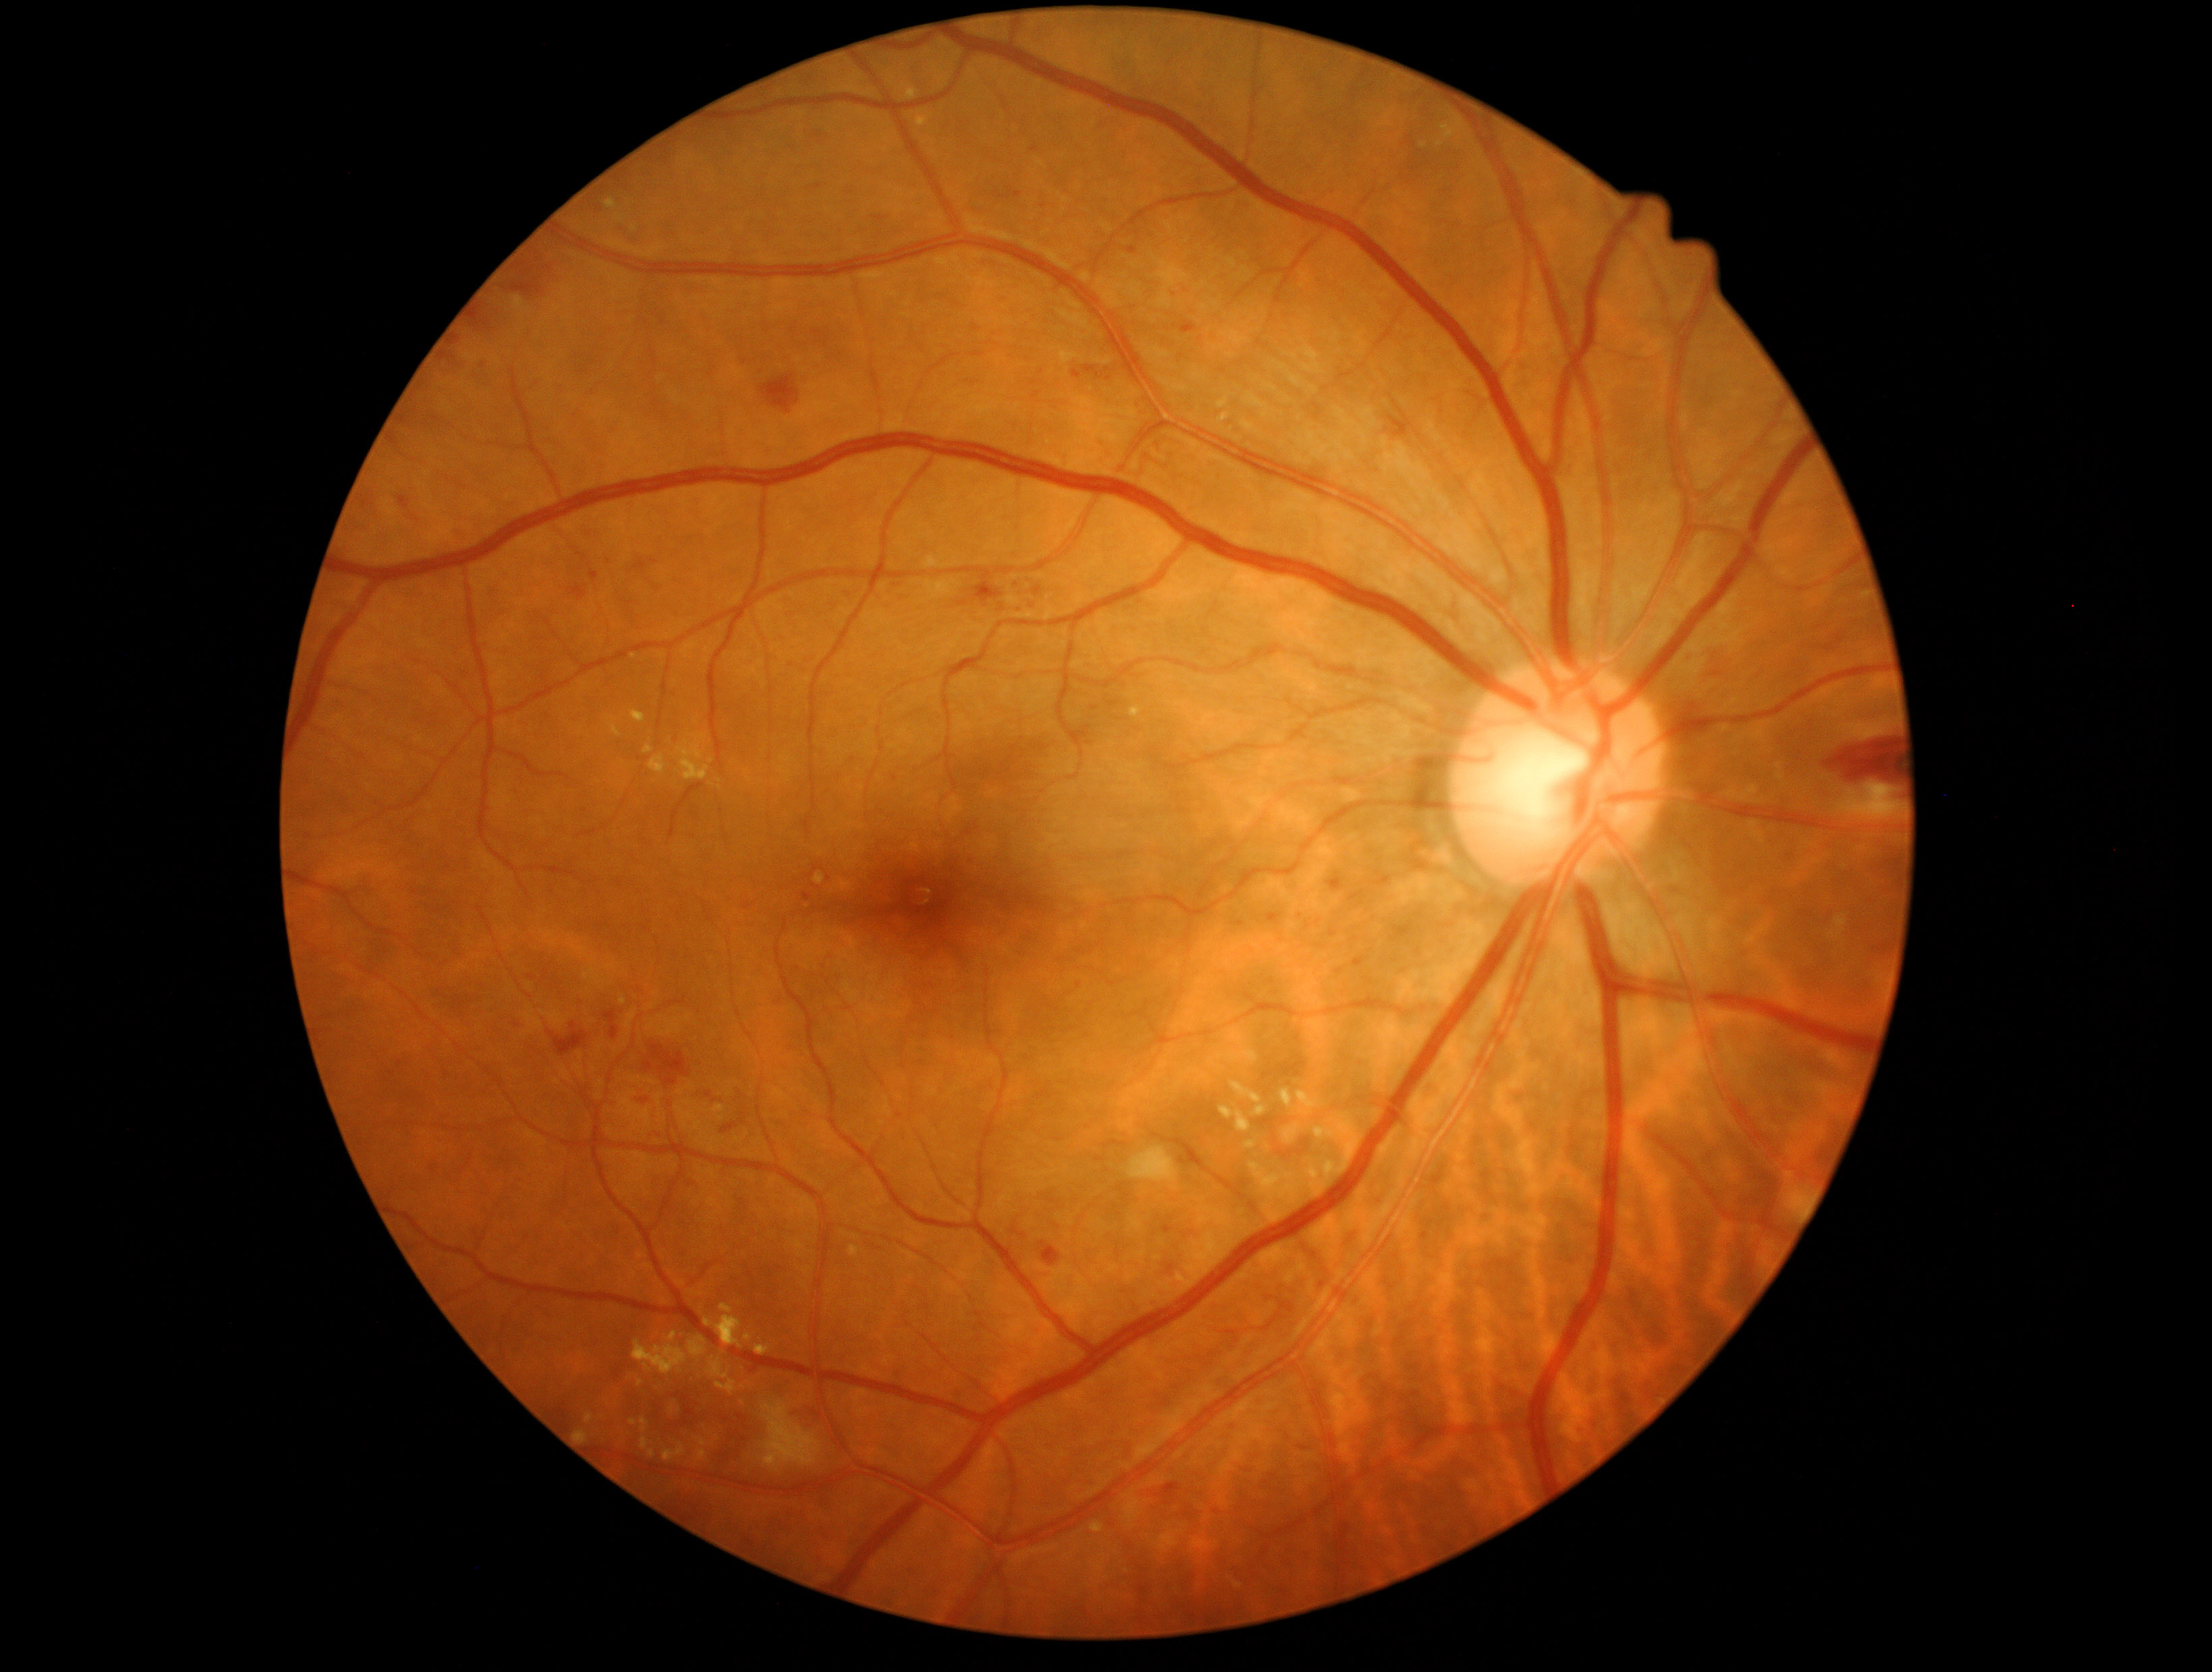

{"partial":true,"dr_grade":2,"lesions":{"ex":[[695,1435,709,1447],[1246,1140,1256,1148],[1308,1167,1321,1193],[606,199,617,208],[849,1245,858,1257],[717,1380,737,1392],[1254,1105,1266,1116],[703,1315,743,1348],[1297,1090,1324,1116],[649,1449,656,1457],[1217,394,1231,409],[662,1442,686,1461],[918,117,929,127],[641,1418,649,1433]],"ex_small":[[720,788],[663,1300],[712,1443]]}}